Posterior pole photograph · camera: NIDEK AFC-230.
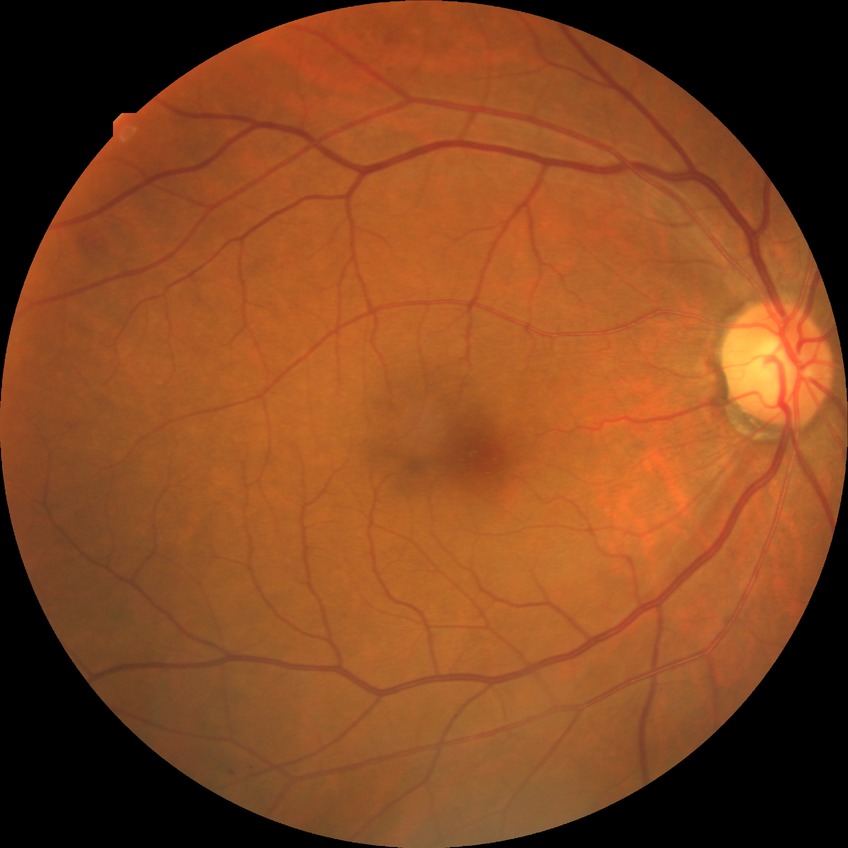 Diabetic retinopathy severity: simple diabetic retinopathy.